Acquired on the Natus RetCam Envision. Wide-field fundus photograph of an infant — 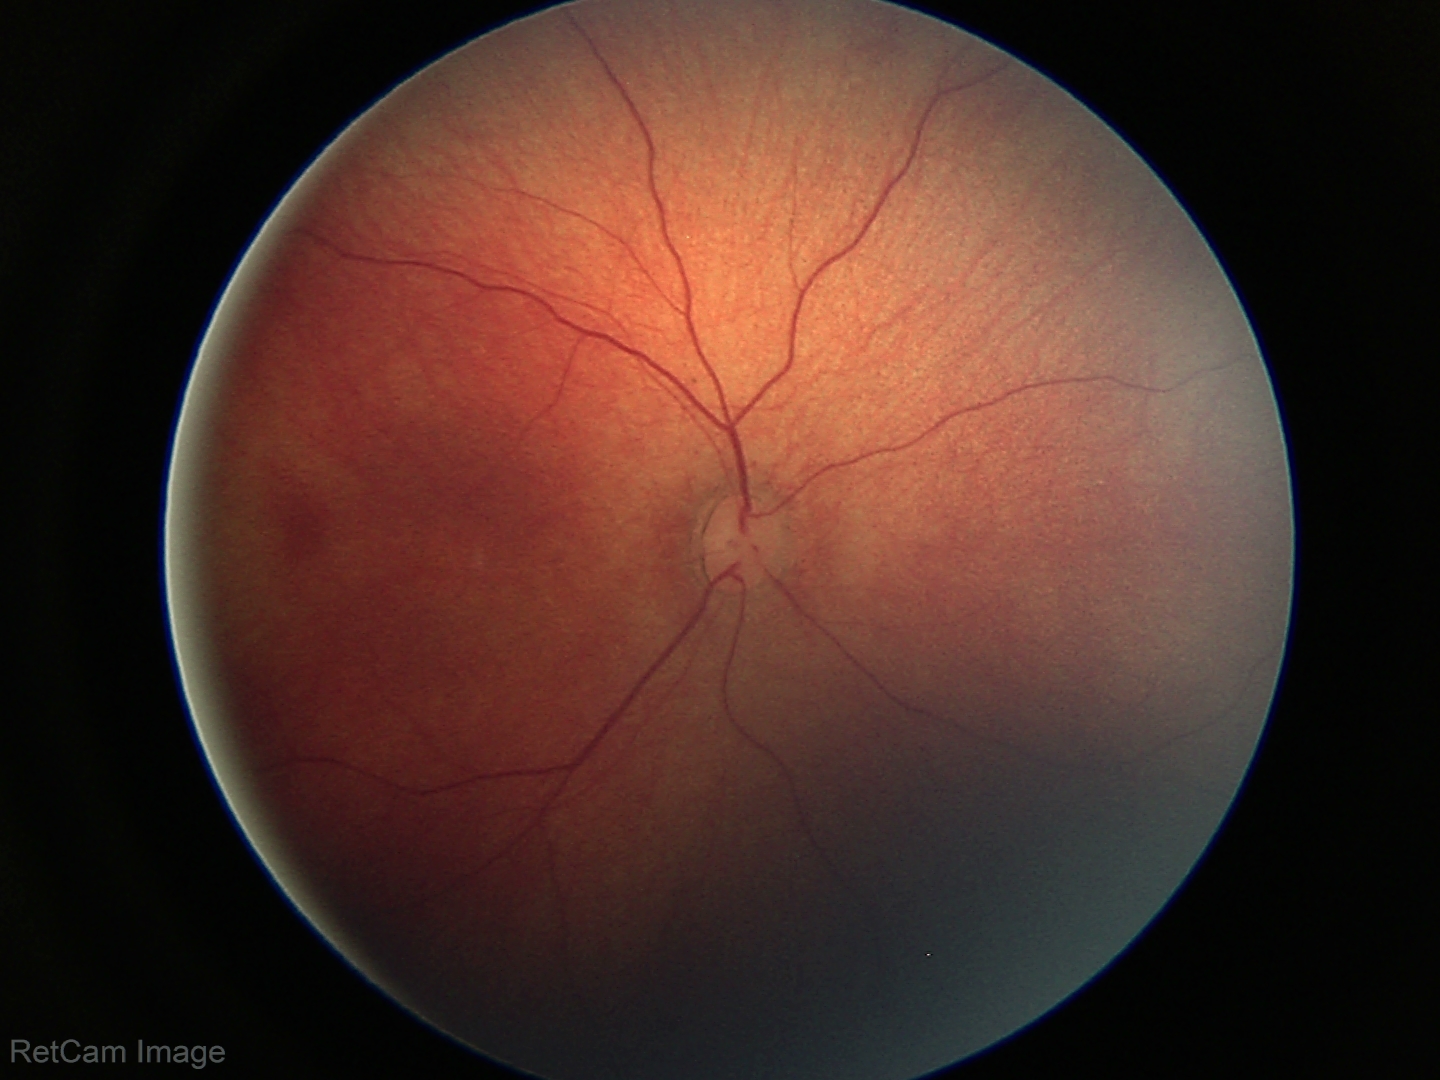

Physiological retinal appearance for postconceptual age.